Image size 512x512; fundus photo:
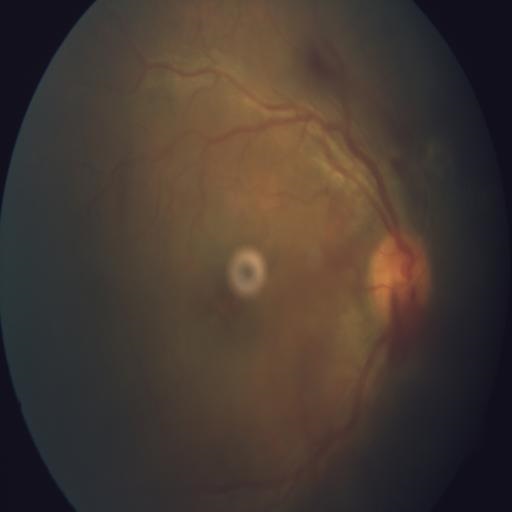
Showing AION (anterior ischemic optic neuropathy).